Phoenix ICON wide-field infant fundus image
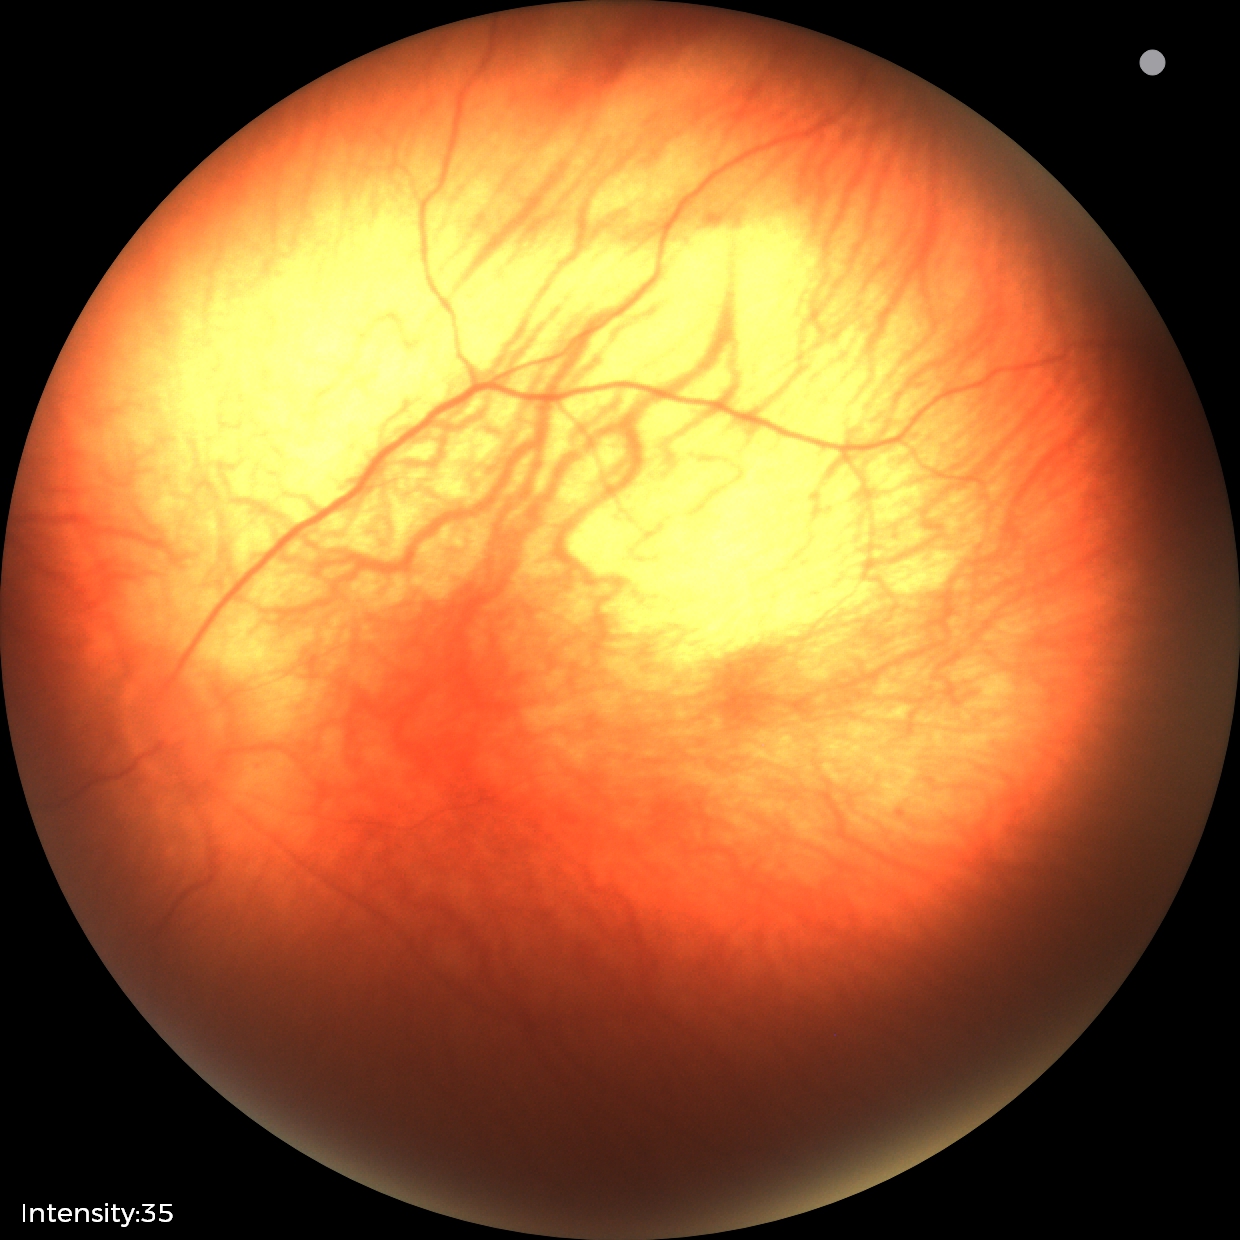 Normal screening examination.